CFP, 240x240px.
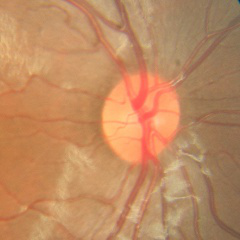 Showing no glaucomatous changes.